Acquired with a NIDEK AFC-230; posterior pole color fundus photograph; image size 848x848; 45° field of view:
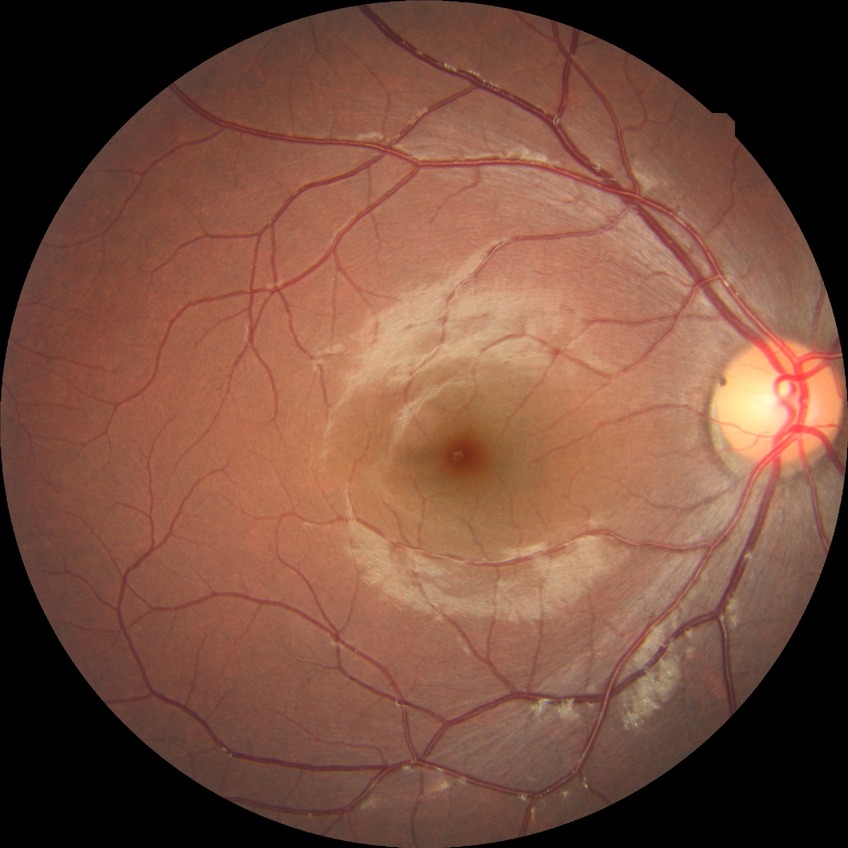 Davis grade is NDR. No diabetic retinal disease findings.